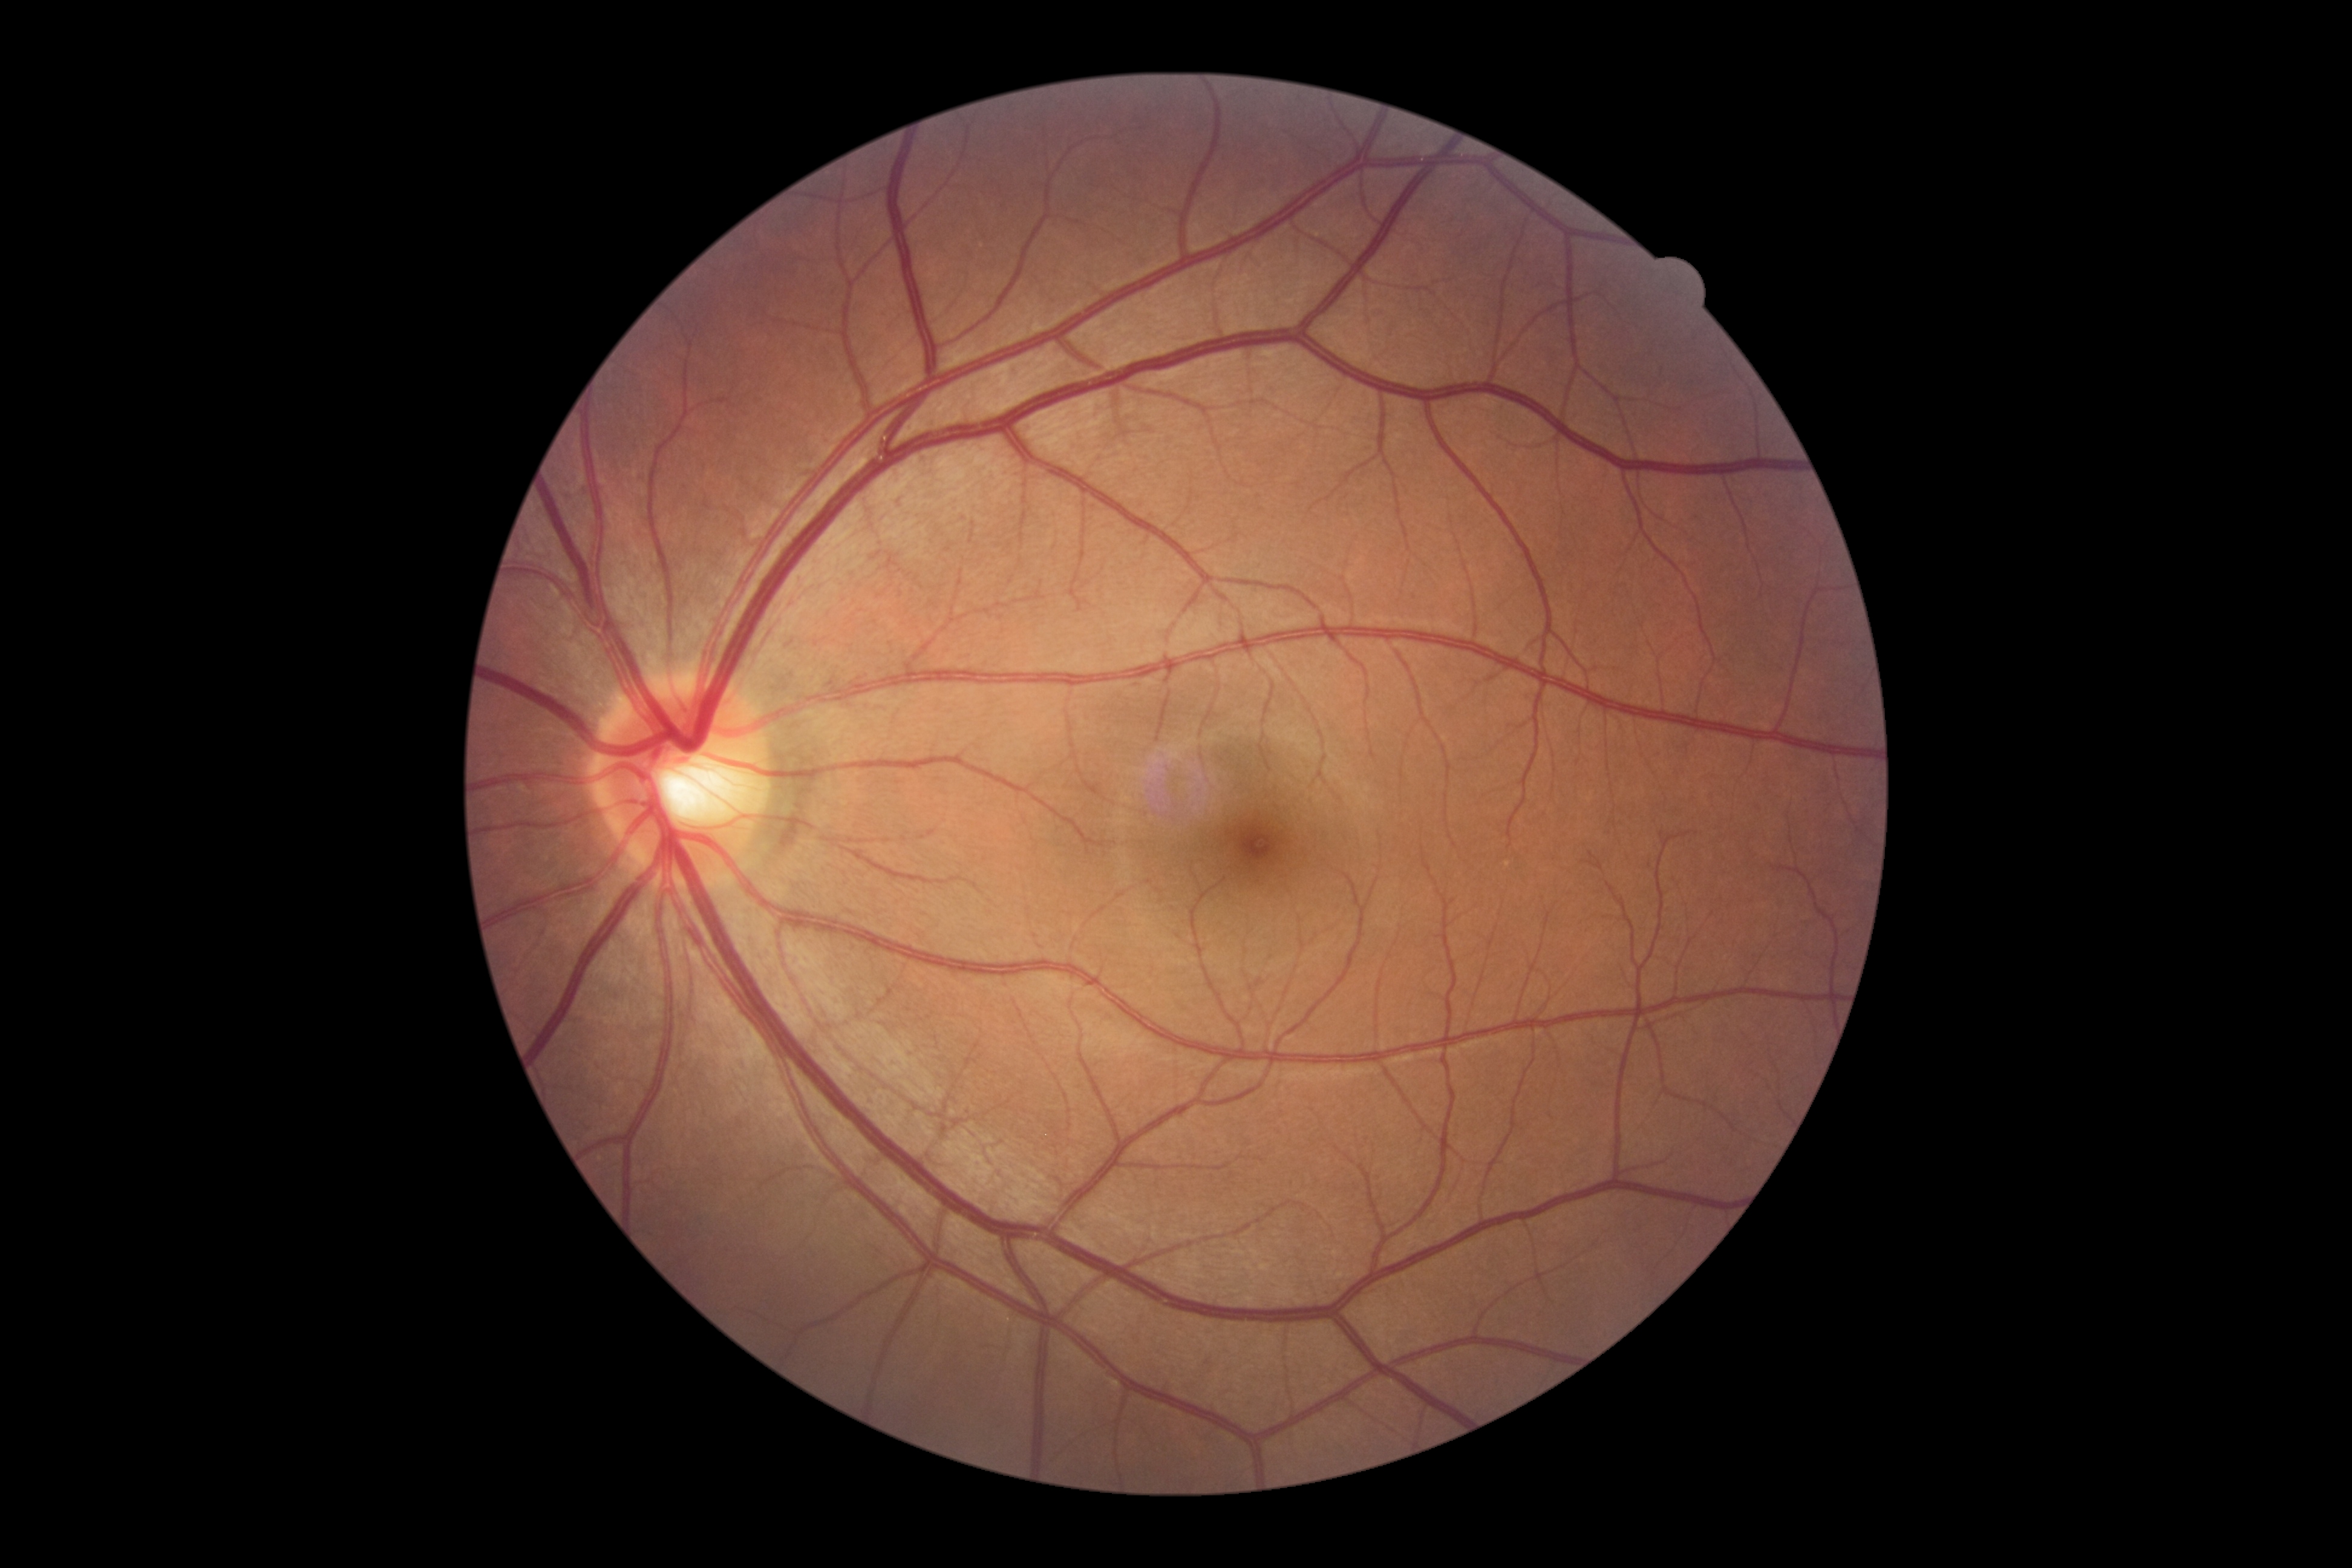

retinopathy: 0.